Image size 1240x1240 · acquired on the Phoenix ICON · pediatric wide-field fundus photograph: 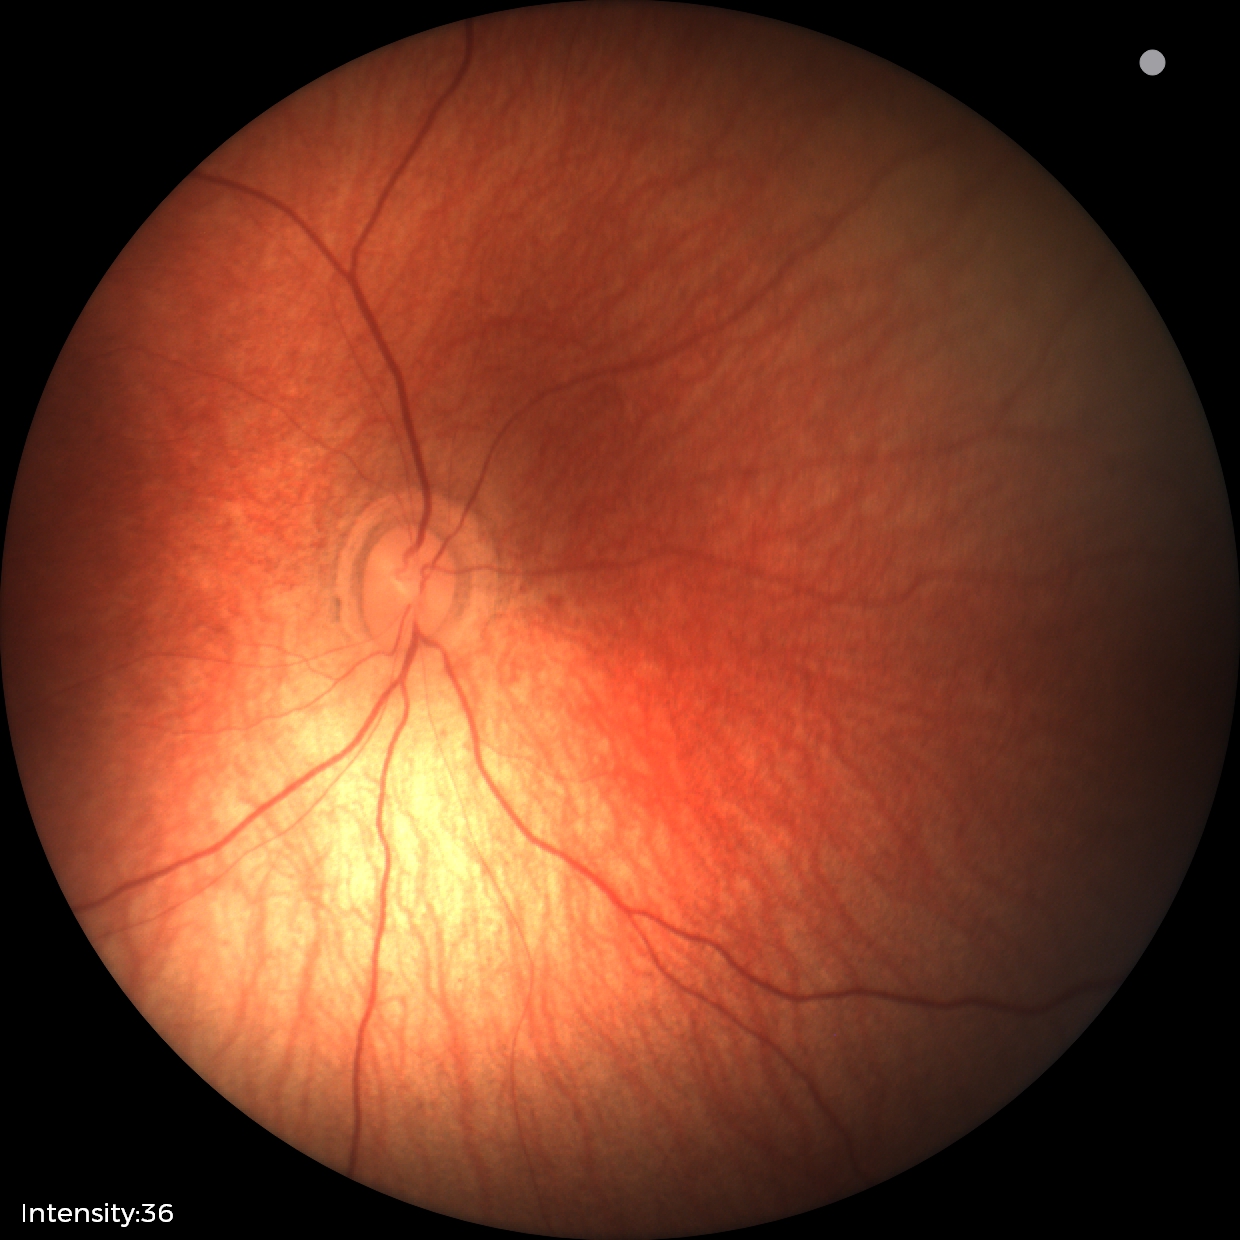

Q: What was the screening finding?
A: physiological retinal finding